Captured on a Remidio smartphone fundus camera
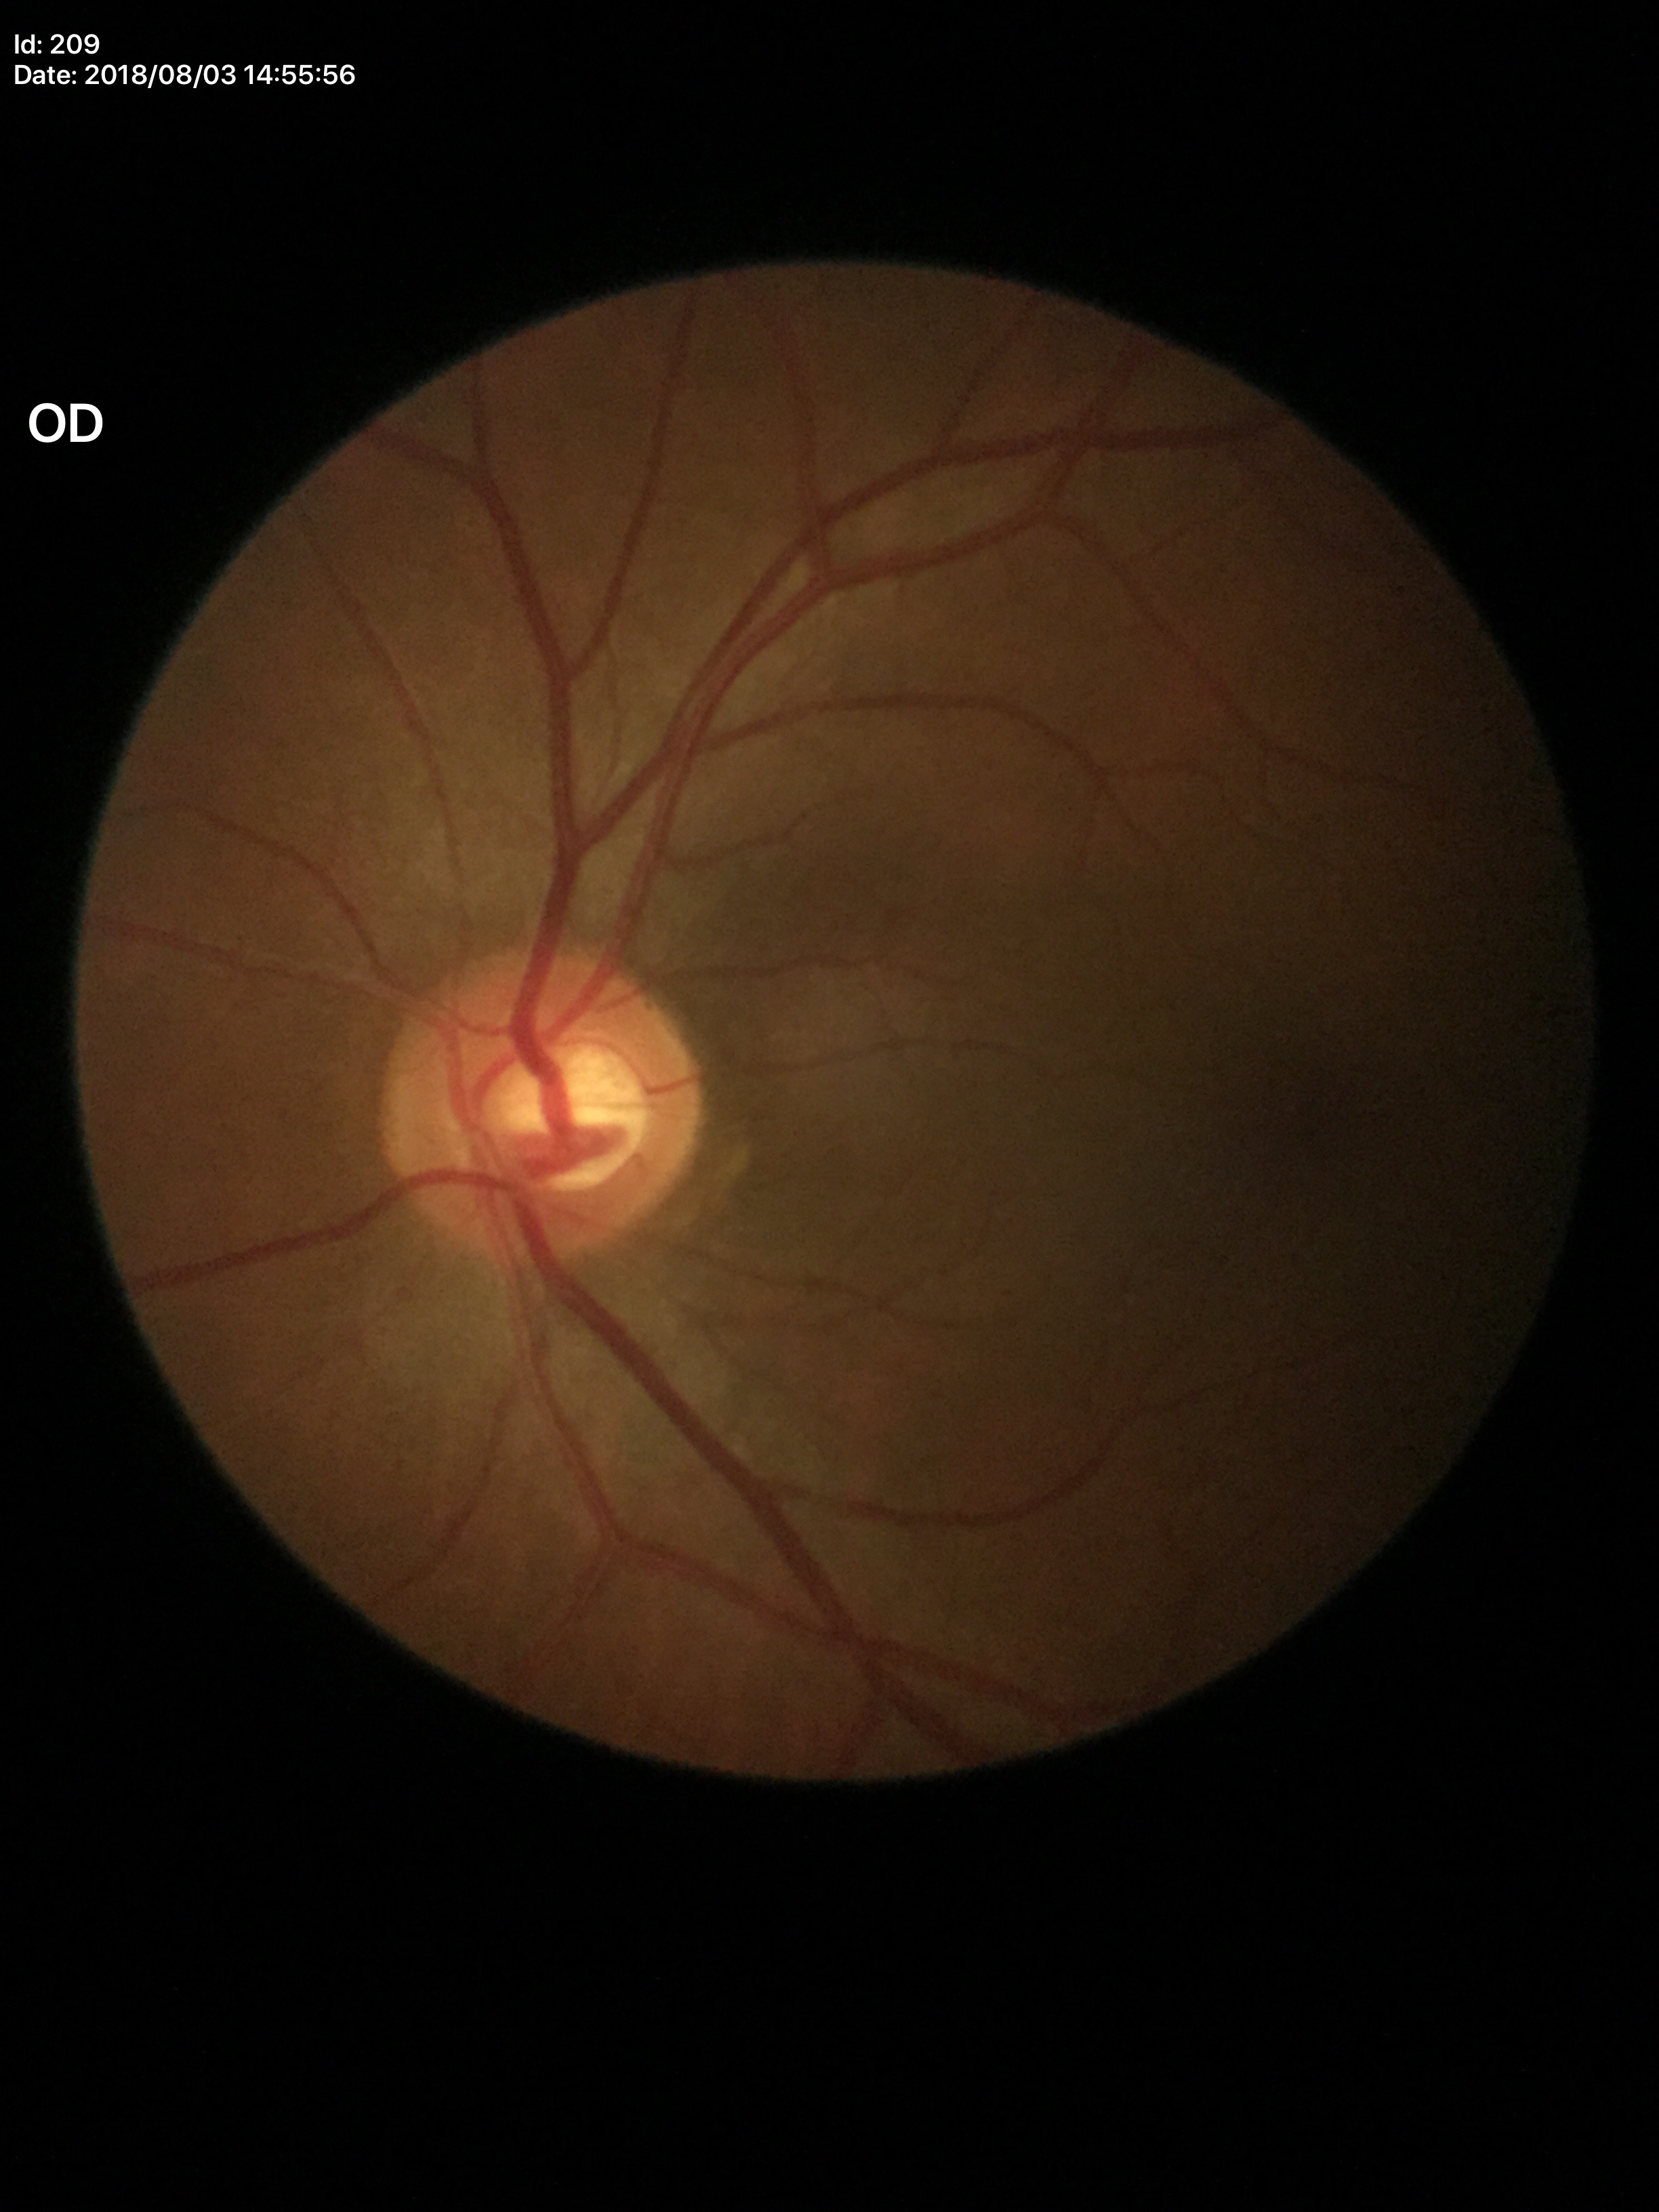

{"glaucoma_decision": "not suspect", "vcdr": "0.52"}